2048 x 1536 pixels: 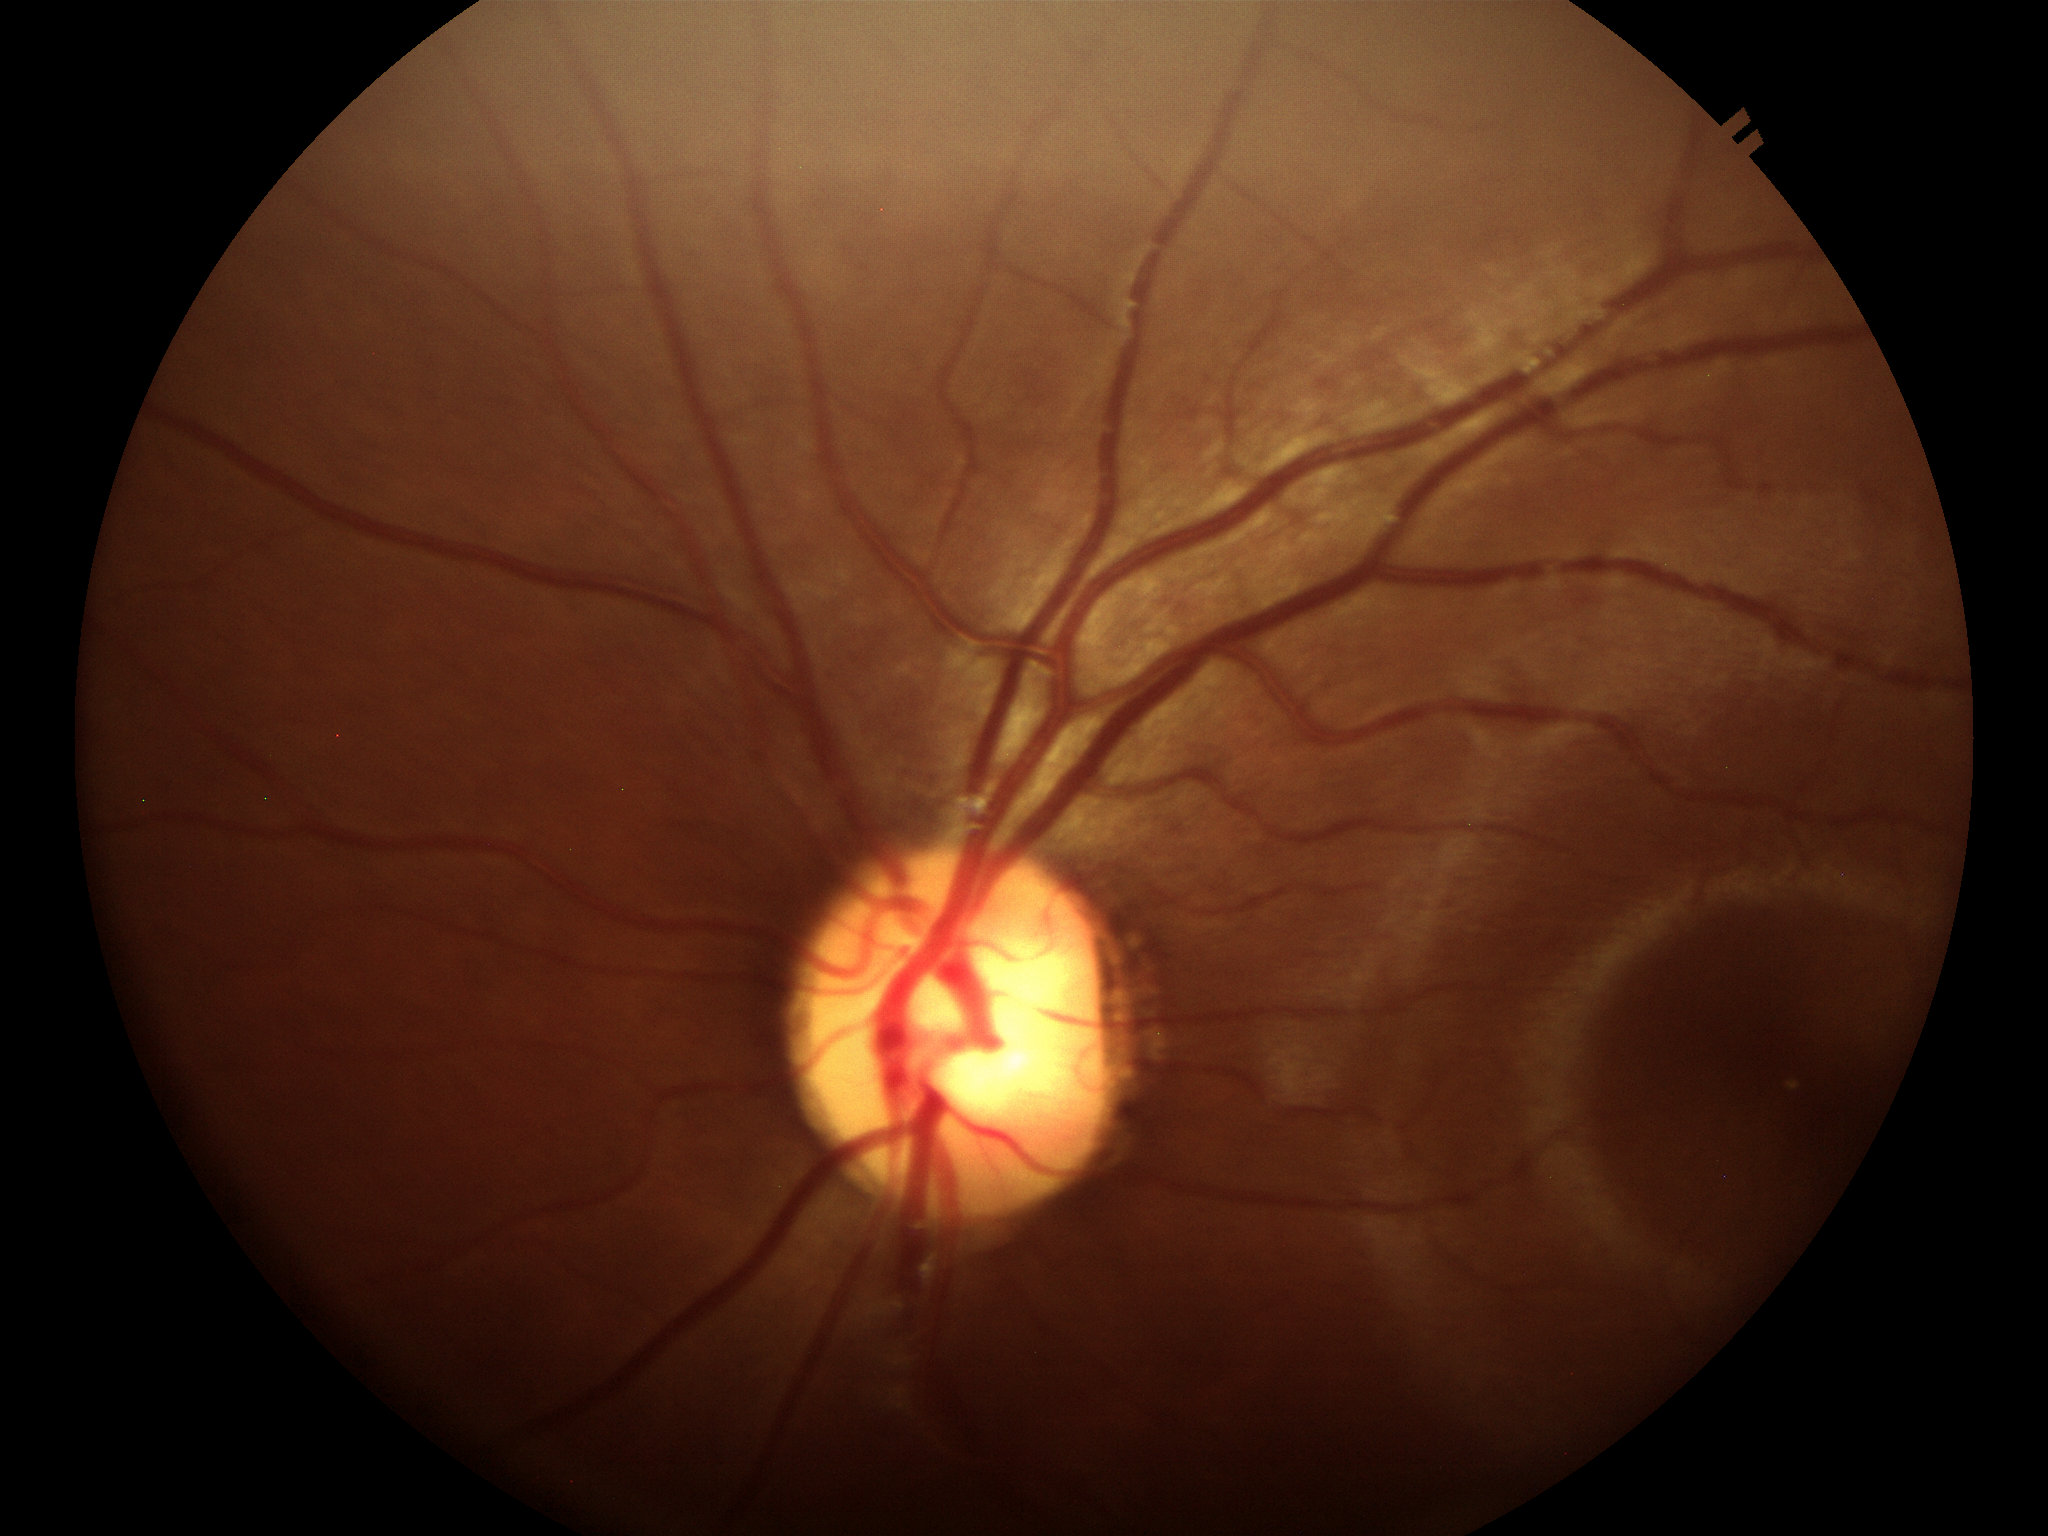
Glaucoma impression: no suspicious findings (all 5 graders called normal) | vertical C/D ratio: 0.54.